DR severity per modified Davis staging, image size 848x848, NIDEK AFC-230 fundus camera:
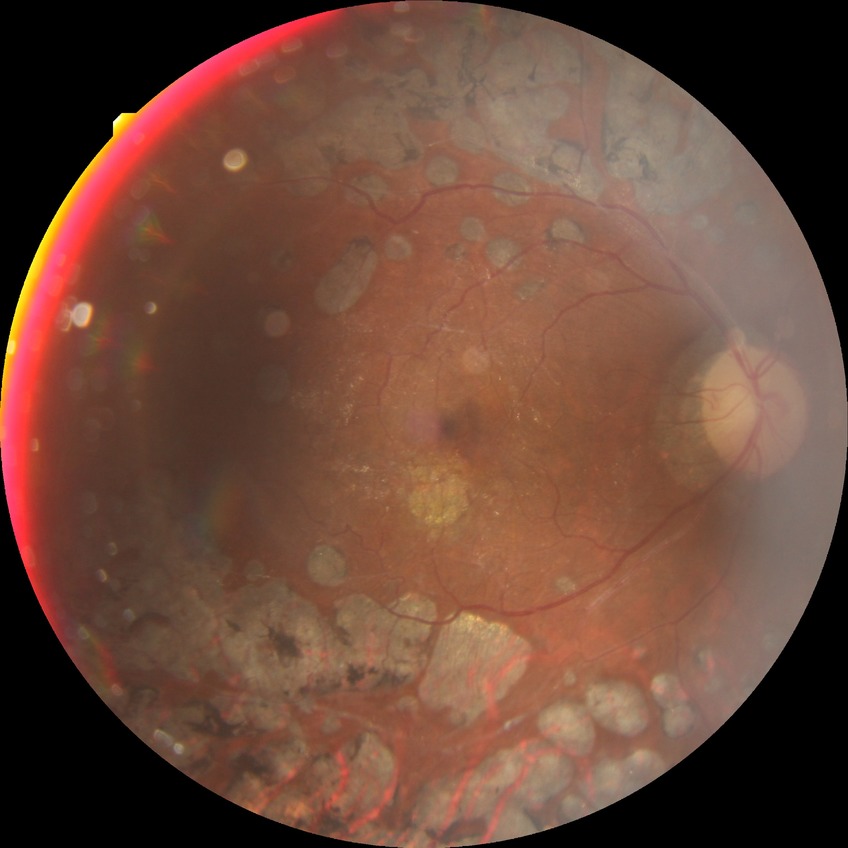
Modified Davis grading is proliferative diabetic retinopathy.